2352 by 1568 pixels. FOV: 45 degrees: 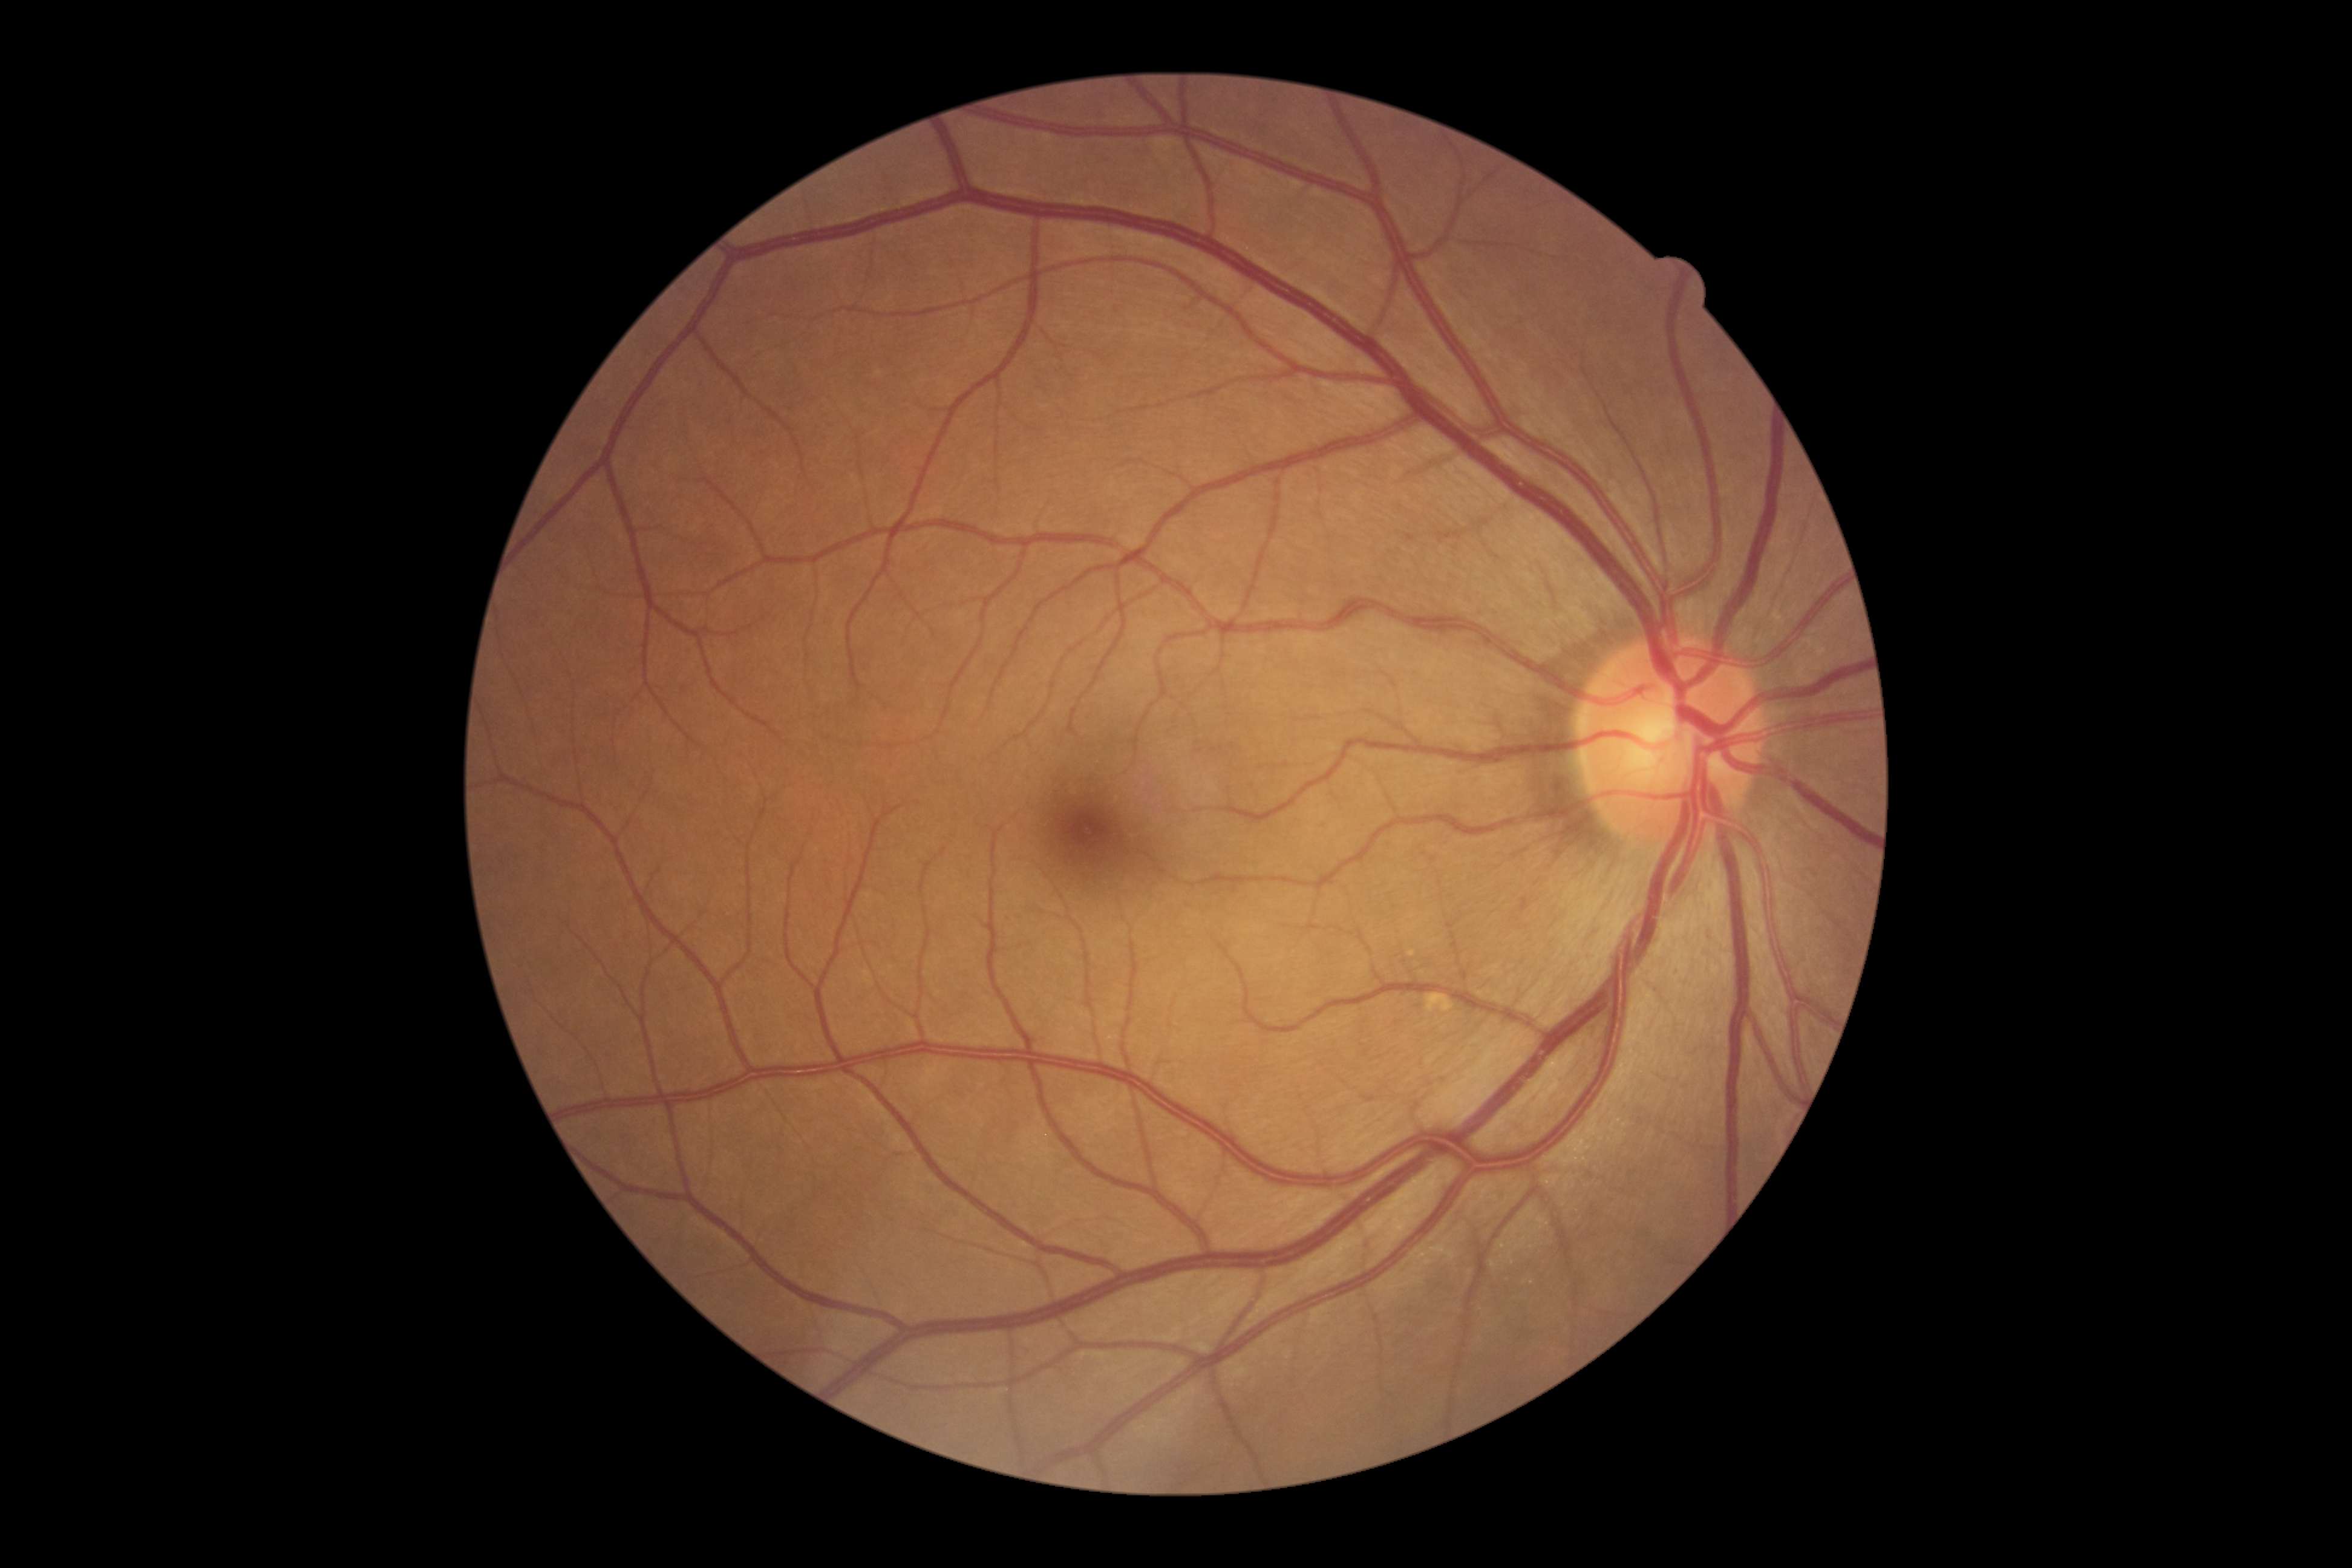
diabetic retinopathy (DR)=no apparent retinopathy (grade 0).